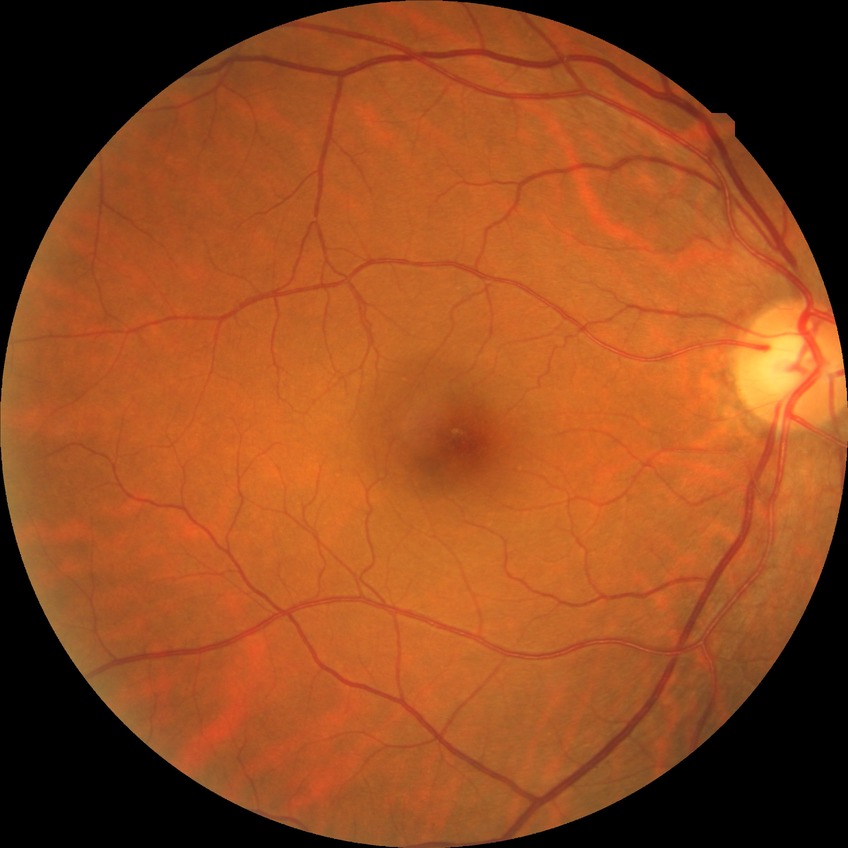
DR stage: NDR.